848x848px · NIDEK AFC-230 · 45° FOV: 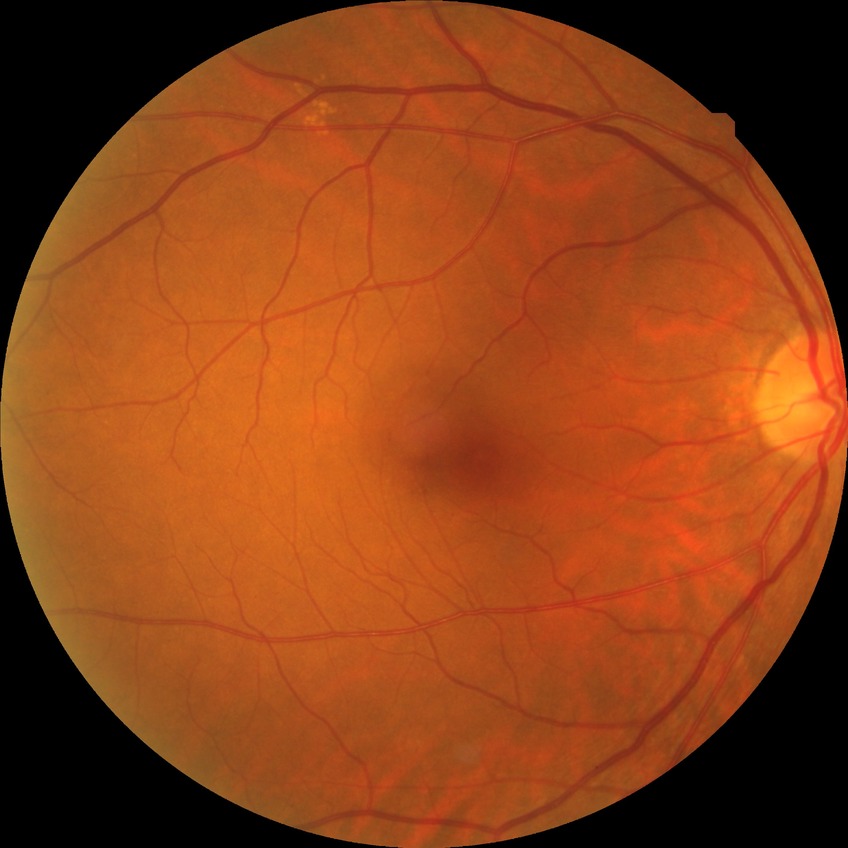

diabetic retinopathy stage: no diabetic retinopathy.